2352x1568px:
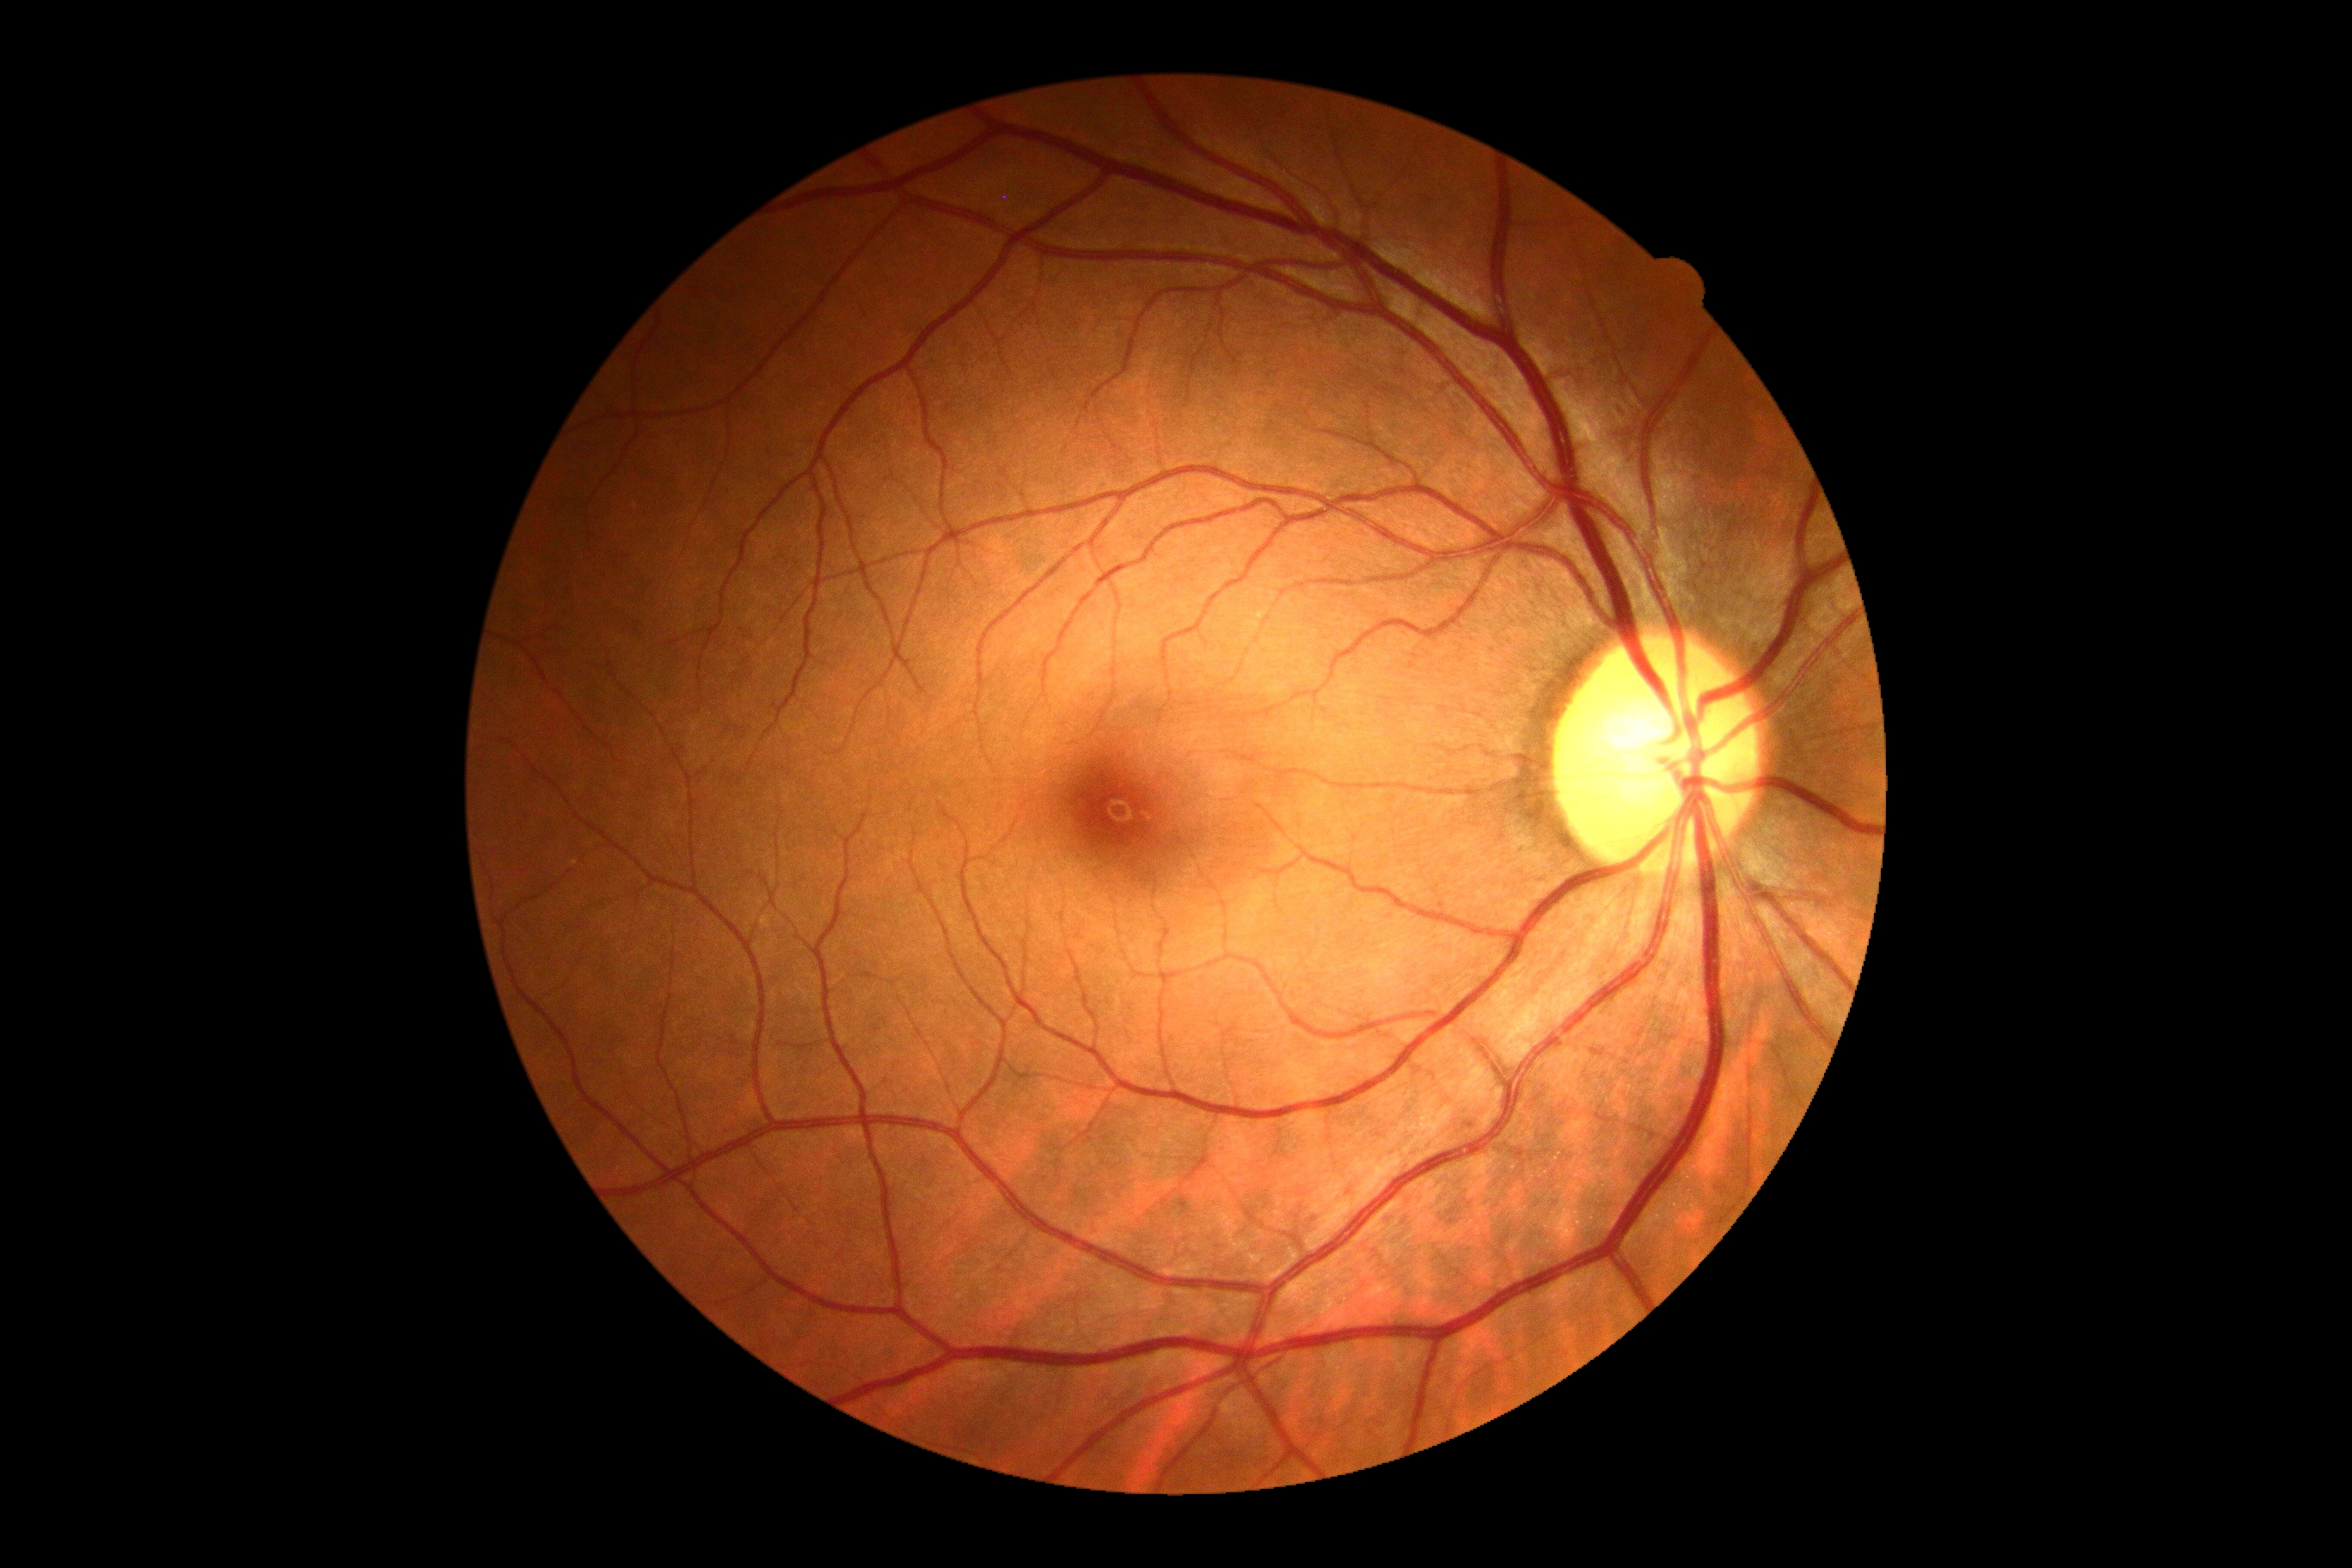 - DR grade — 0/4